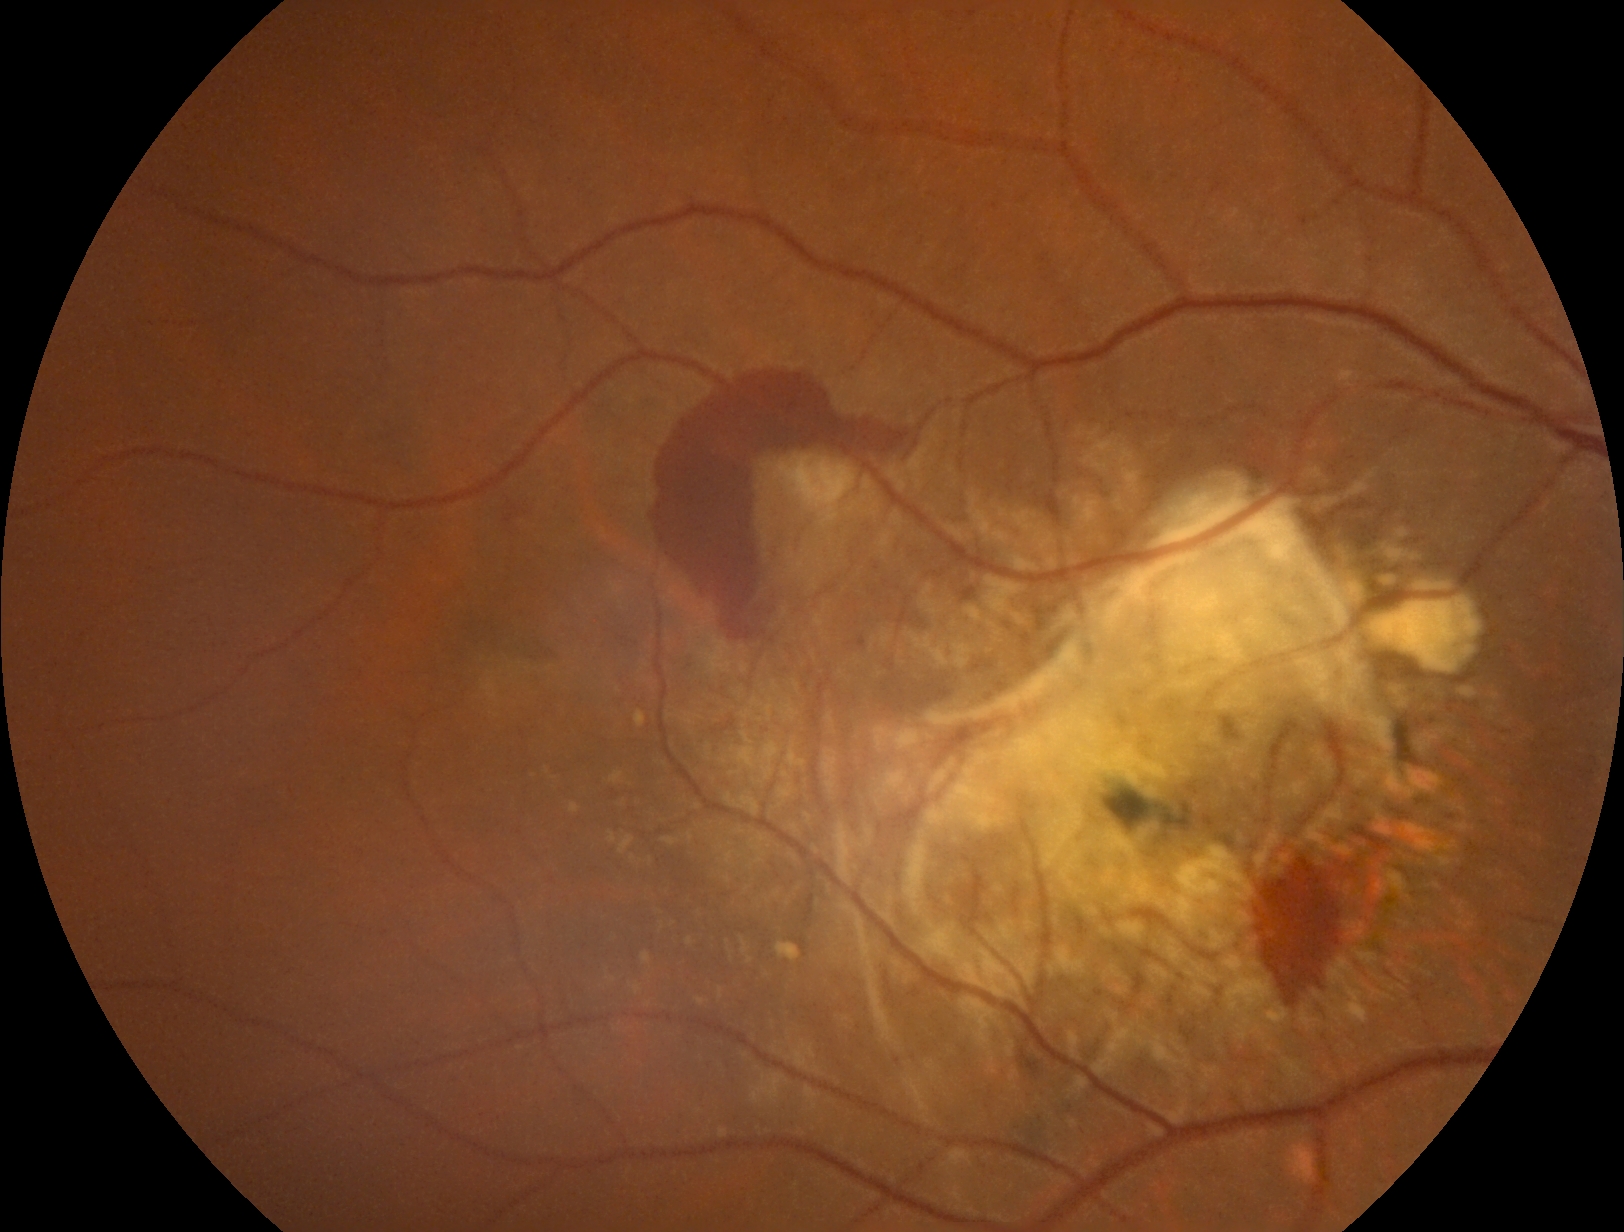 {"dr_grade": "proliferative diabetic retinopathy (grade 4)"}